Captured on a Topcon TRC-50DX fundus camera · captured after pupil dilation.
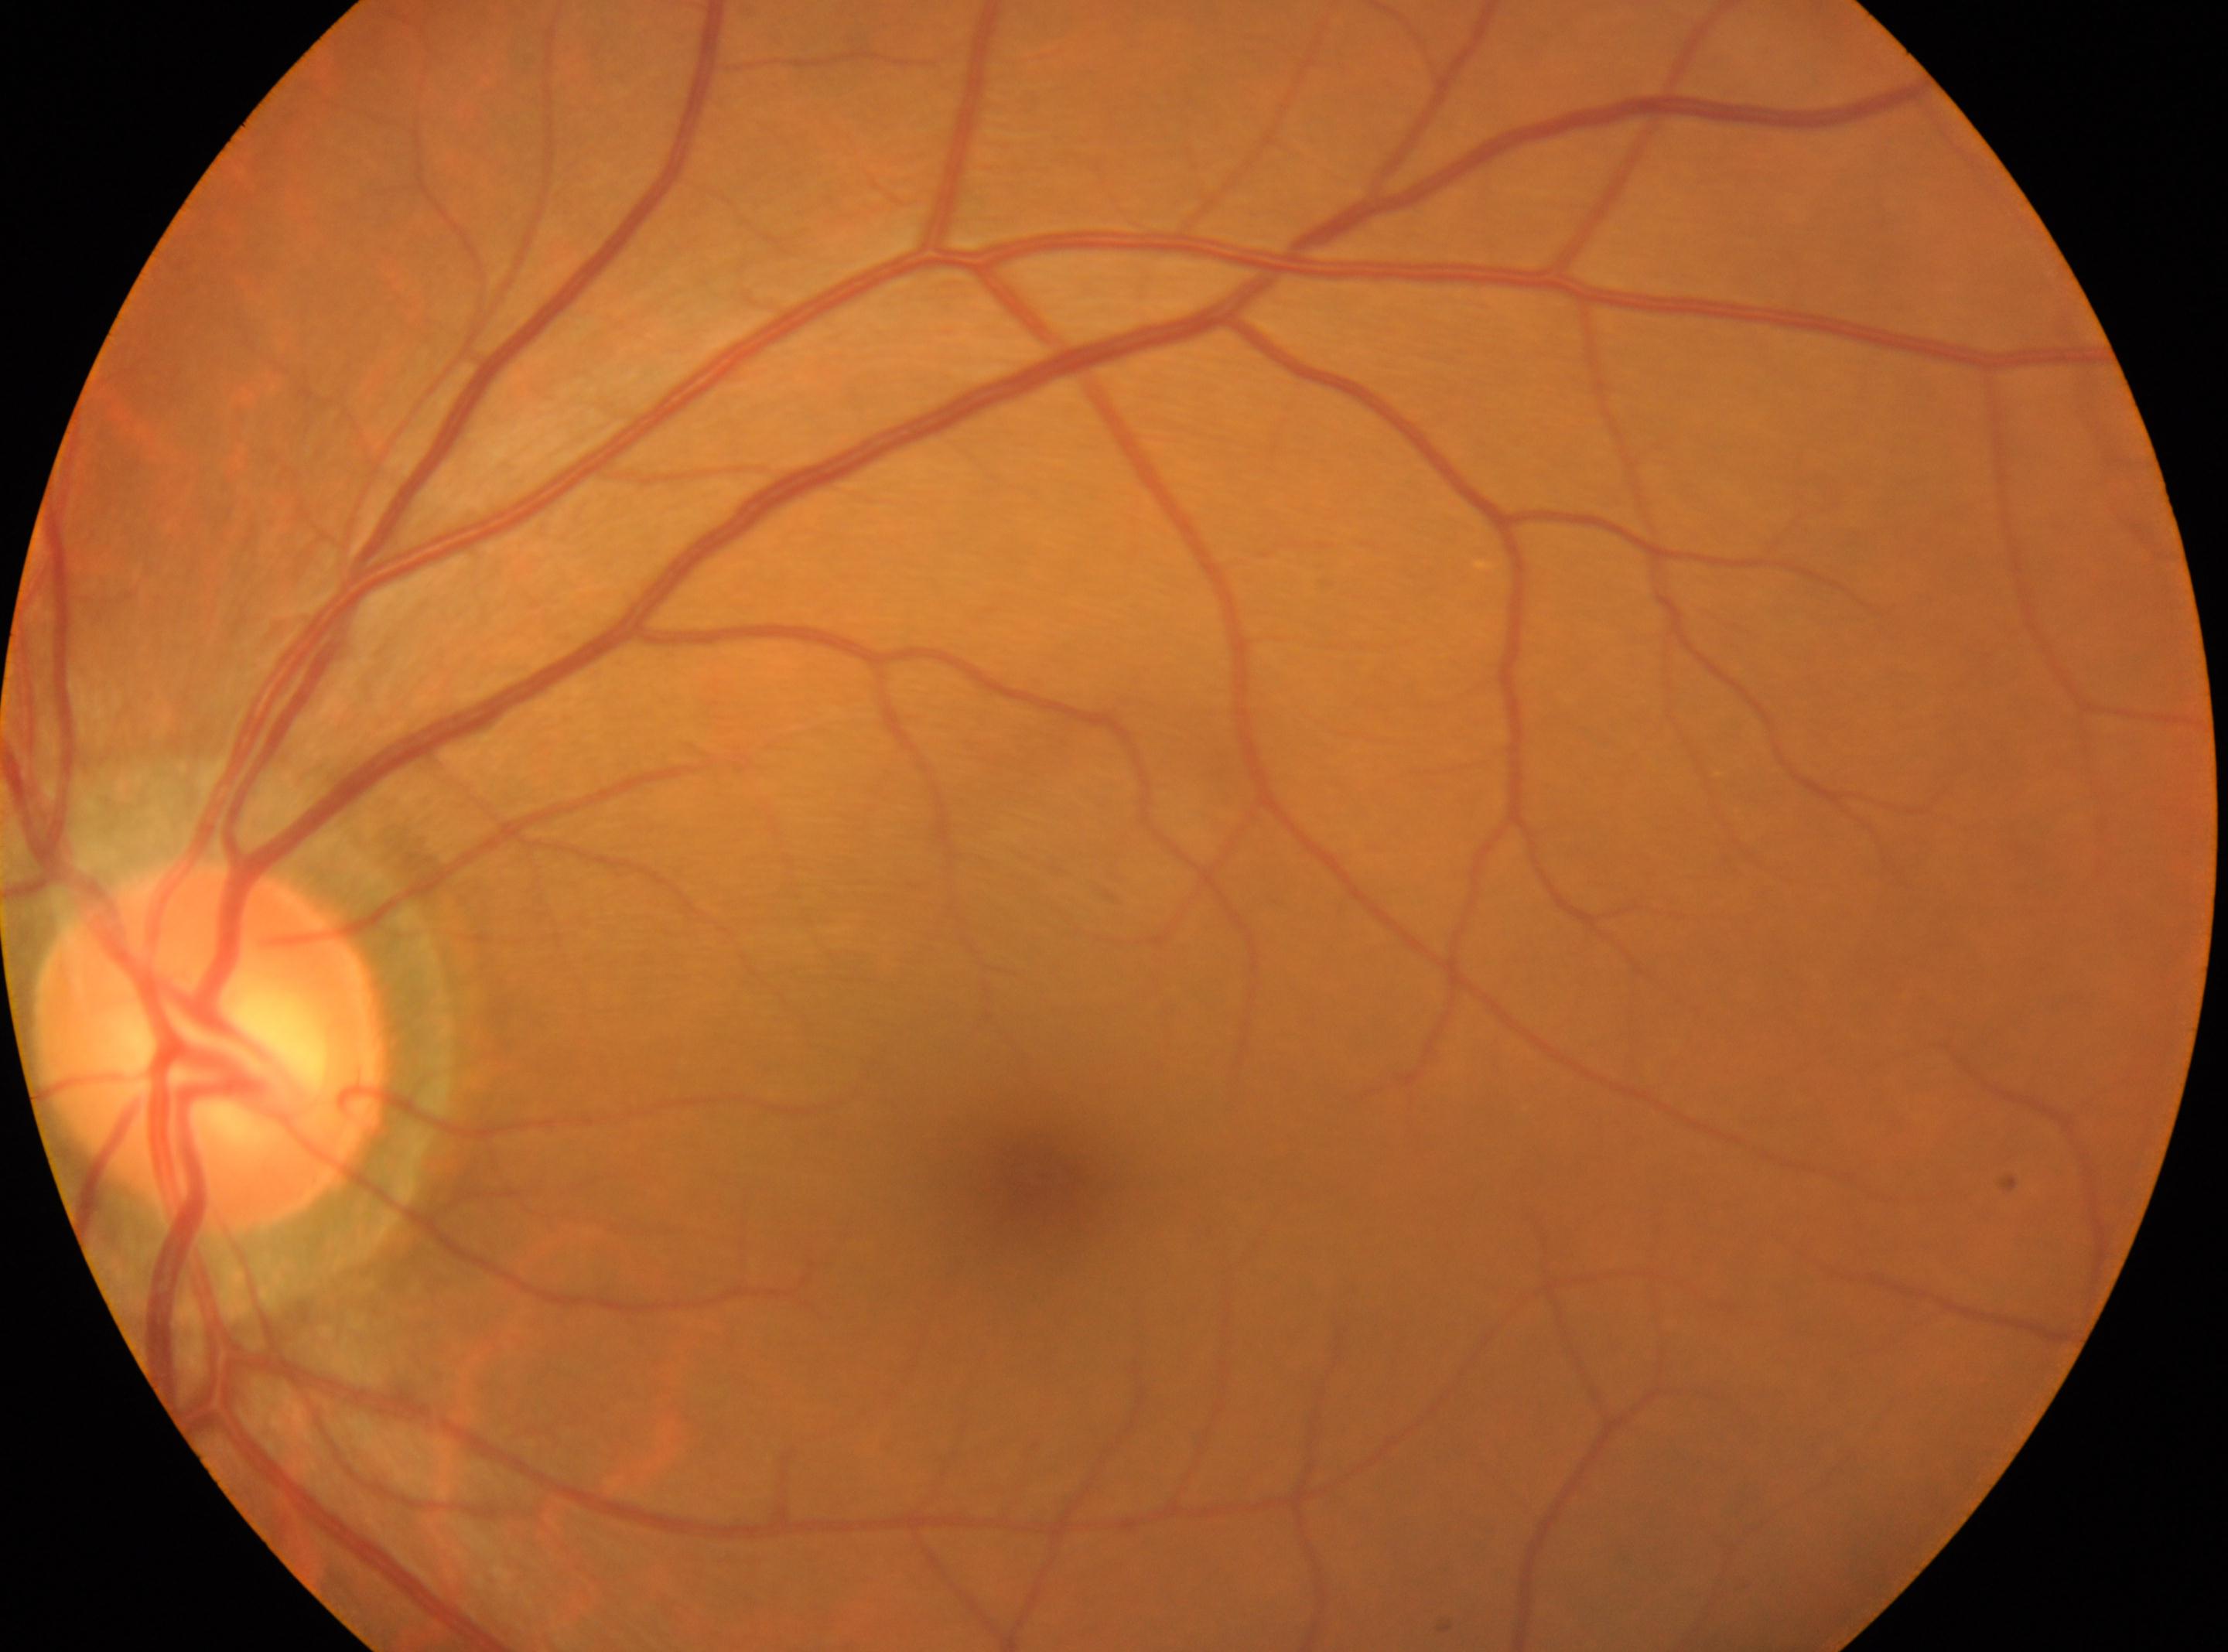

Optic disc: 206px, 1049px. The image shows the left eye. Macular center: 1040px, 1176px. DR severity: no apparent retinopathy (grade 0).